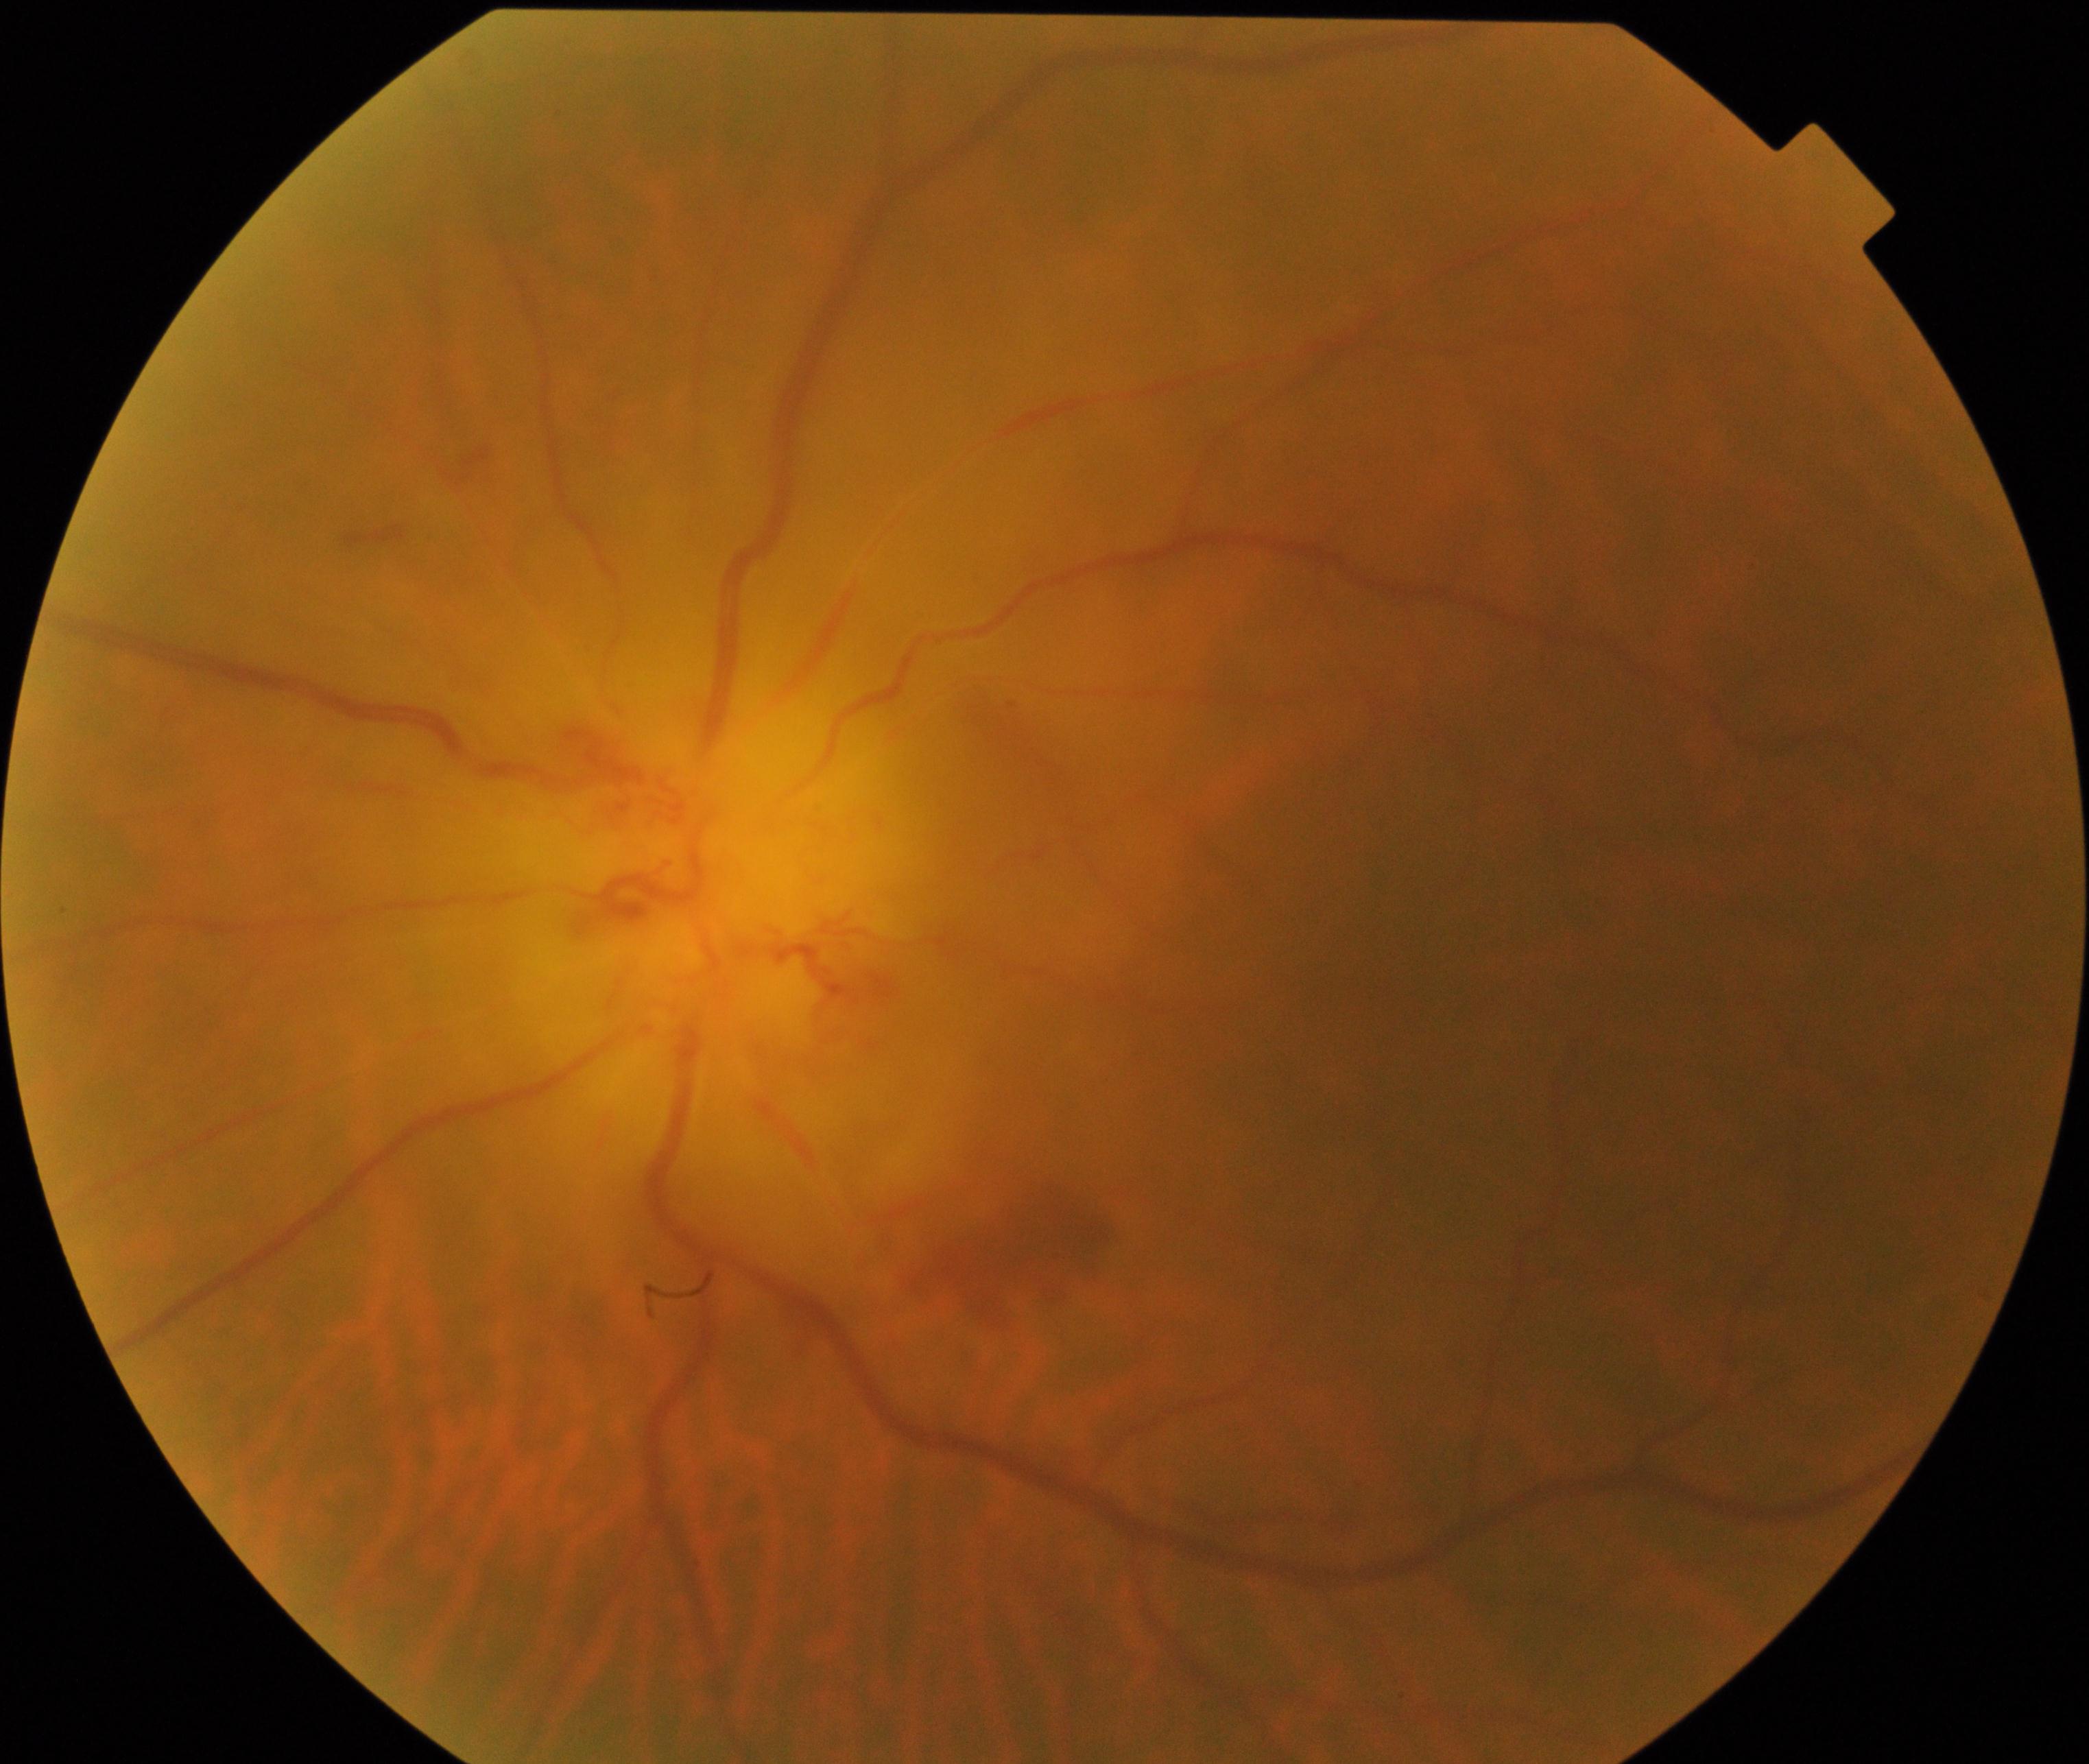

Fundus appearance consistent with disc swelling and elevation.